45 degree fundus photograph; retinal fundus photograph.
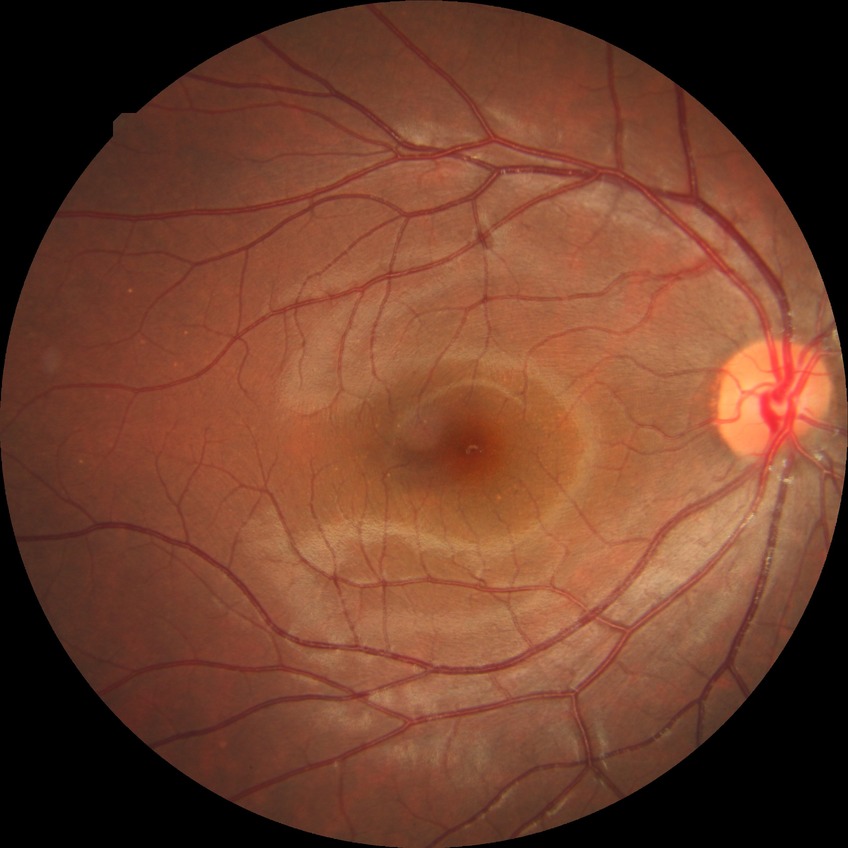
Davis grading = no diabetic retinopathy.